Modified Davis grading, camera: NIDEK AFC-230
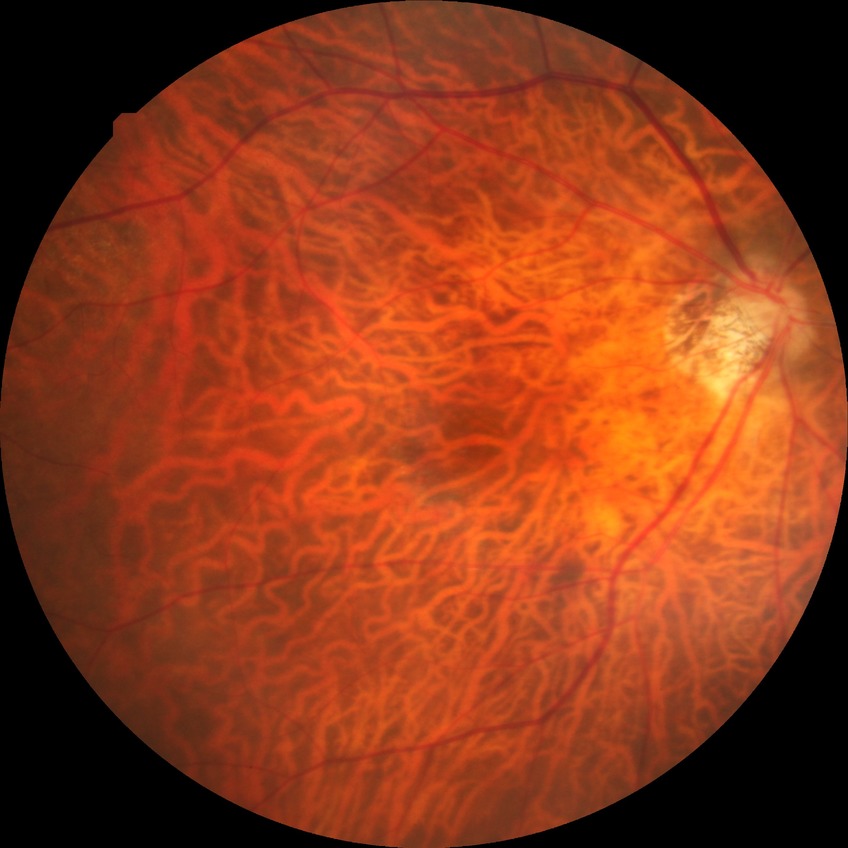

diabetic retinopathy (DR) = NDR (no diabetic retinopathy)